Posterior pole photograph. Modified Davis grading. Nonmydriatic. 45-degree field of view. NIDEK AFC-230: 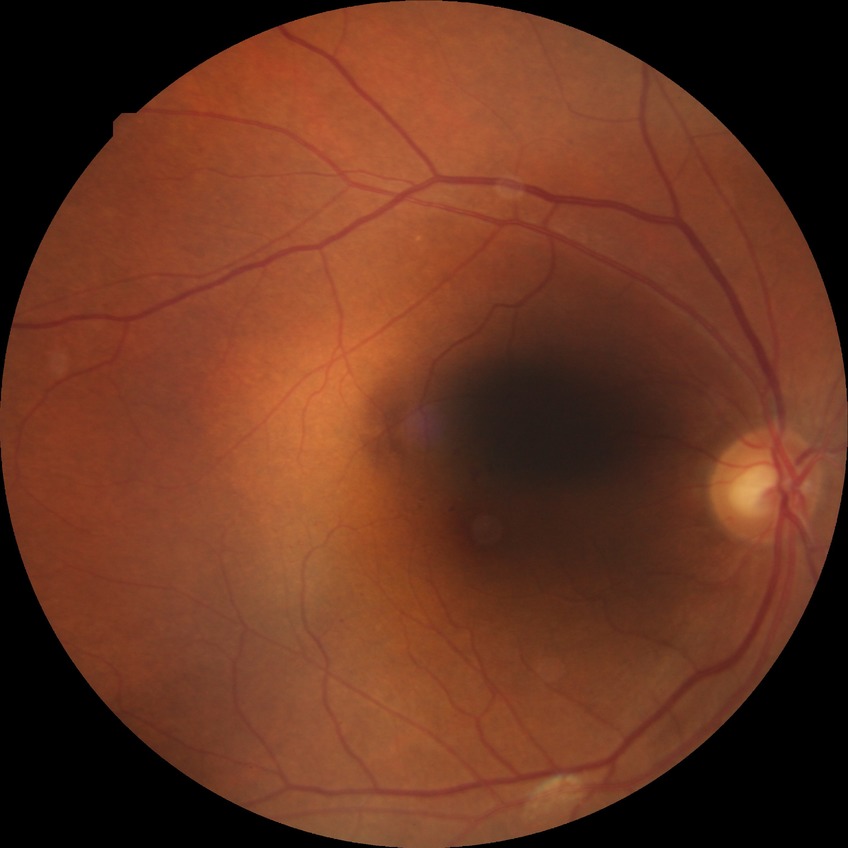
Diabetic retinopathy (DR): SDR (simple diabetic retinopathy).
Disease class: non-proliferative diabetic retinopathy.